2102x1736px:
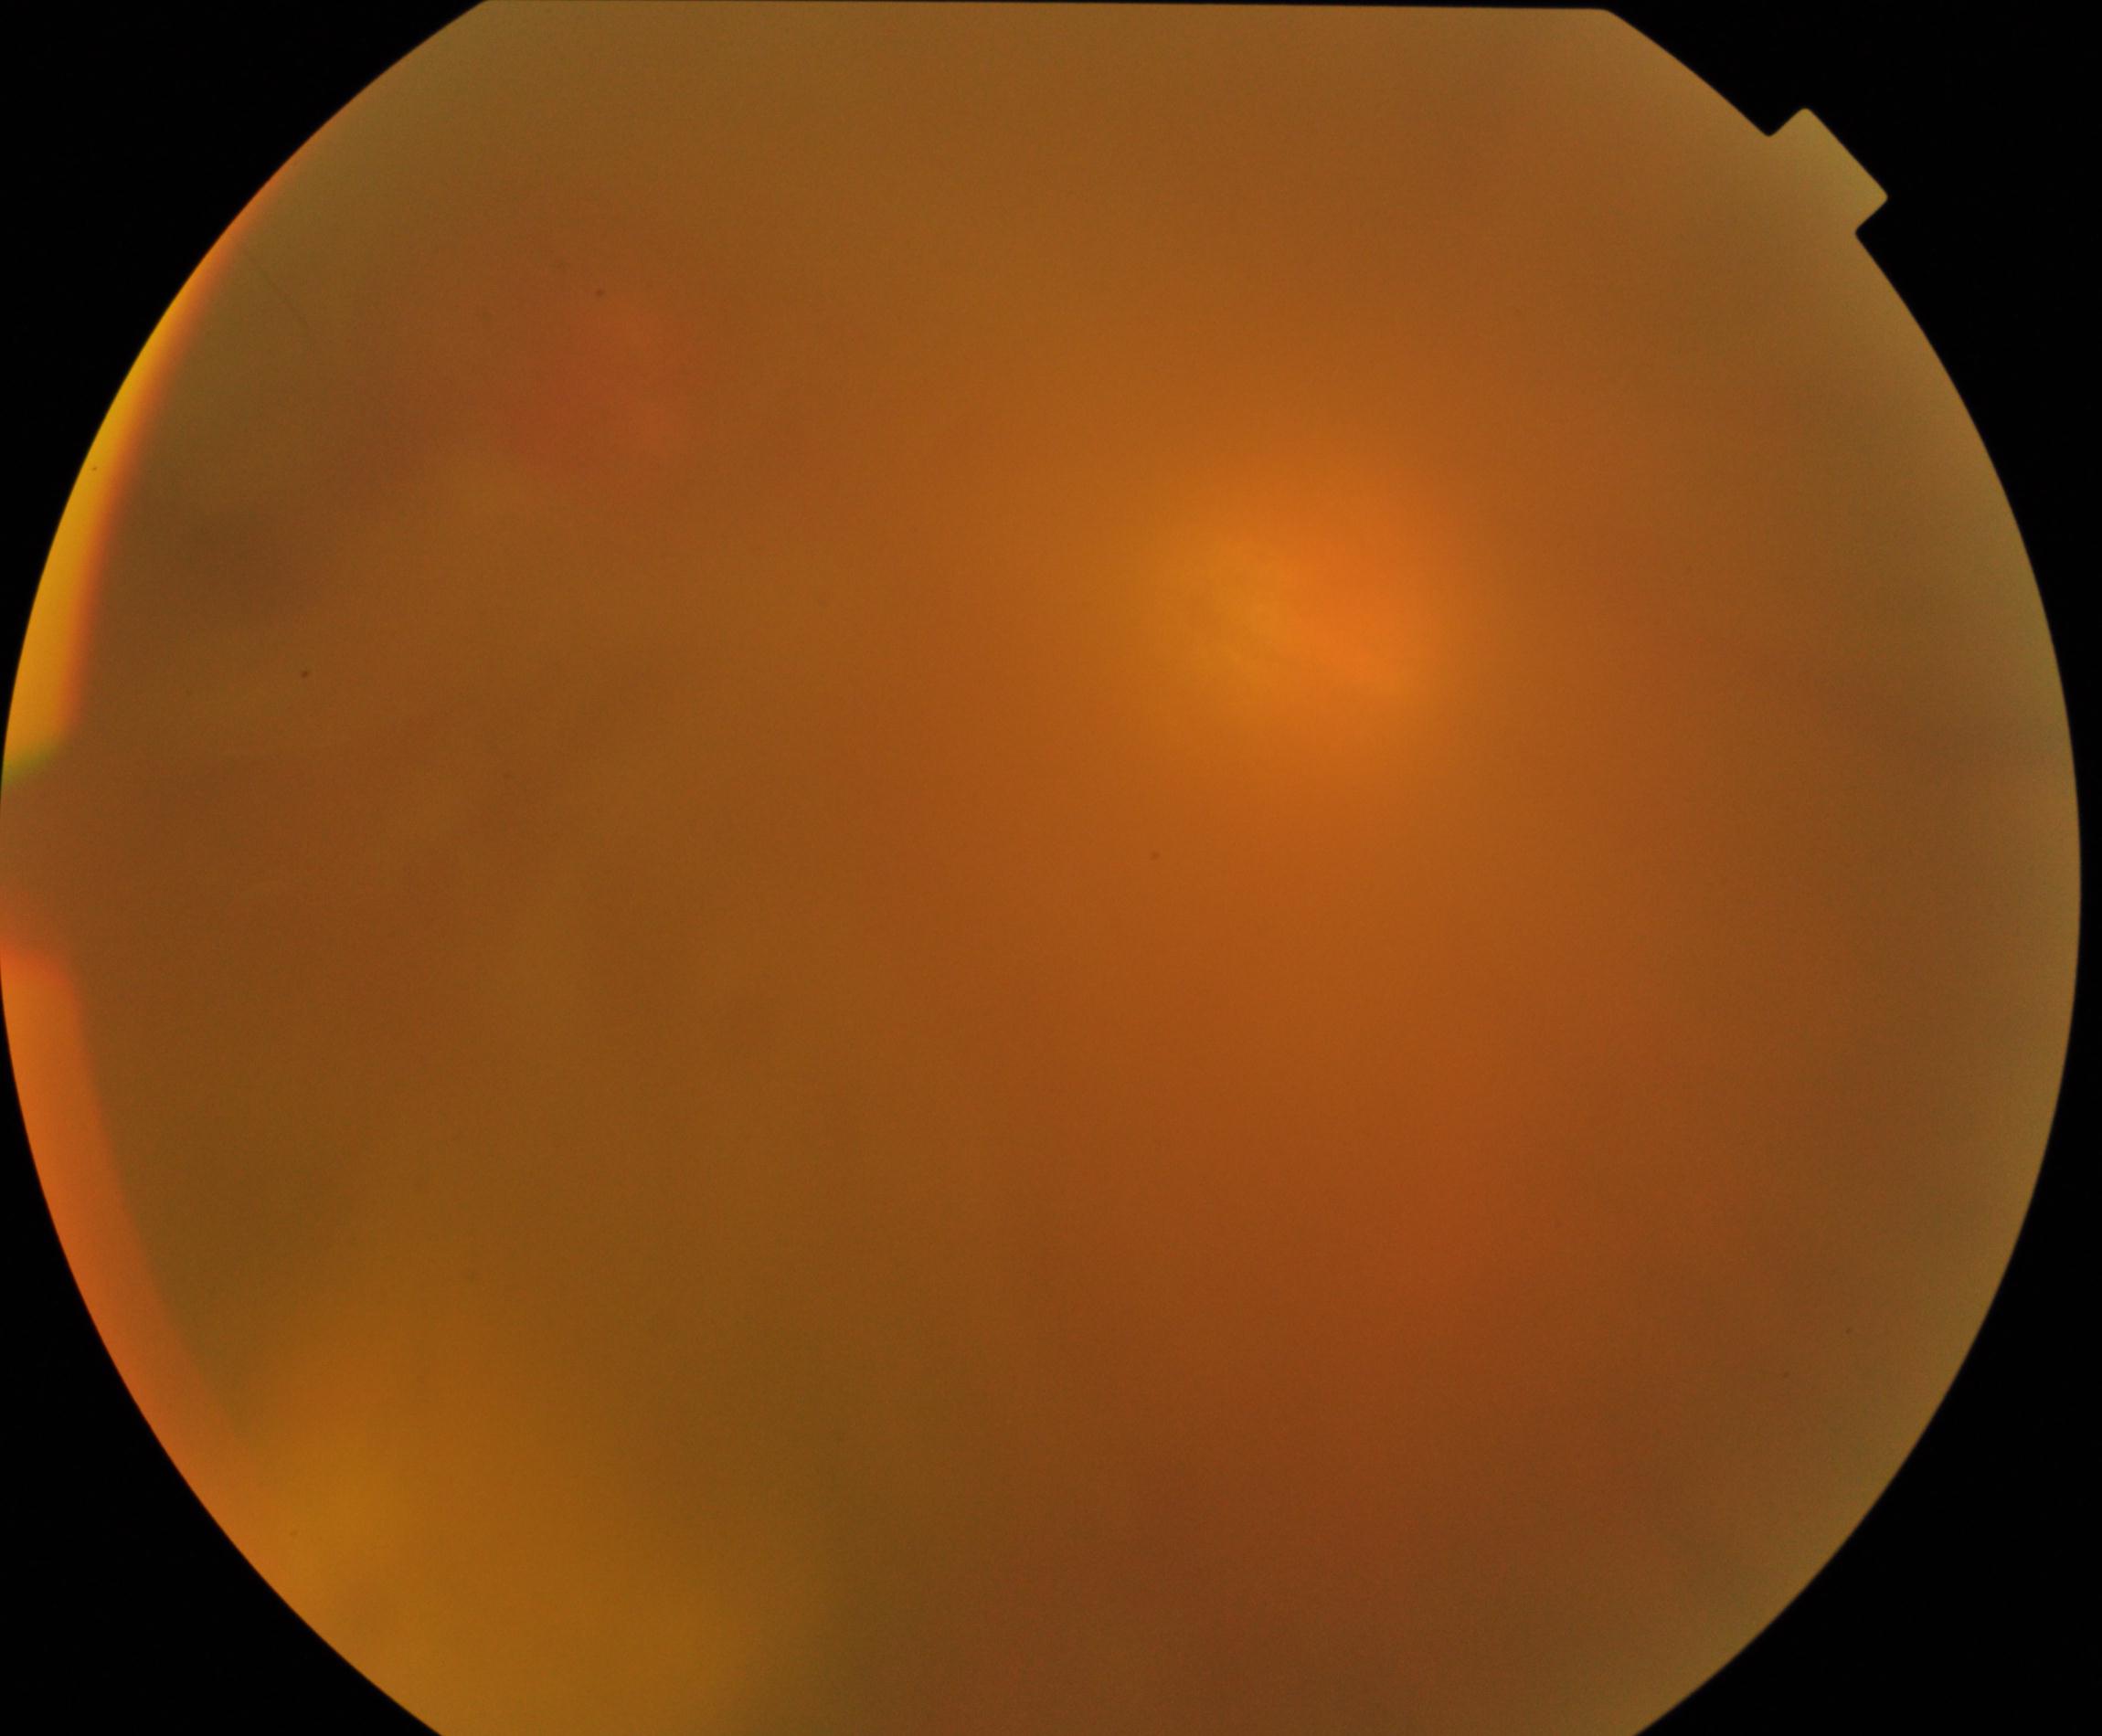 Image quality: poor, substantial obscuration of retinal landmarks. Proliferative diabetic retinopathy: not identified.